No pharmacologic dilation, 848 x 848 pixels
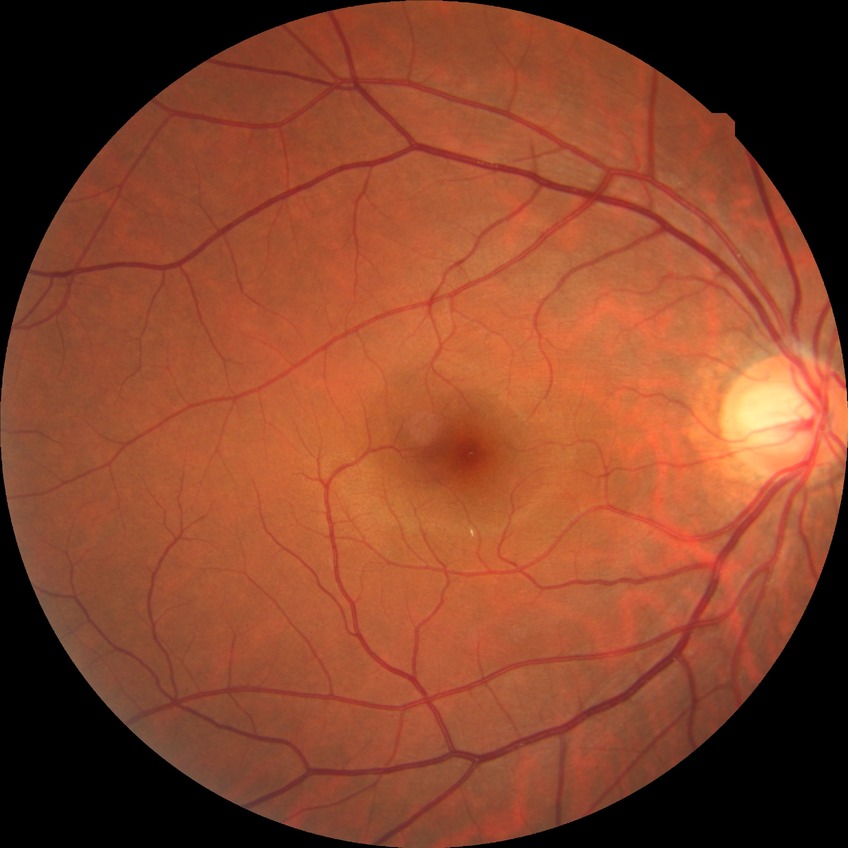

Assessment:
- diabetic retinopathy (DR) — NDR (no diabetic retinopathy)